Camera: NIDEK AFC-230 · no pharmacologic dilation · FOV: 45 degrees · 848 x 848 pixels · diabetic retinopathy graded by the modified Davis classification — 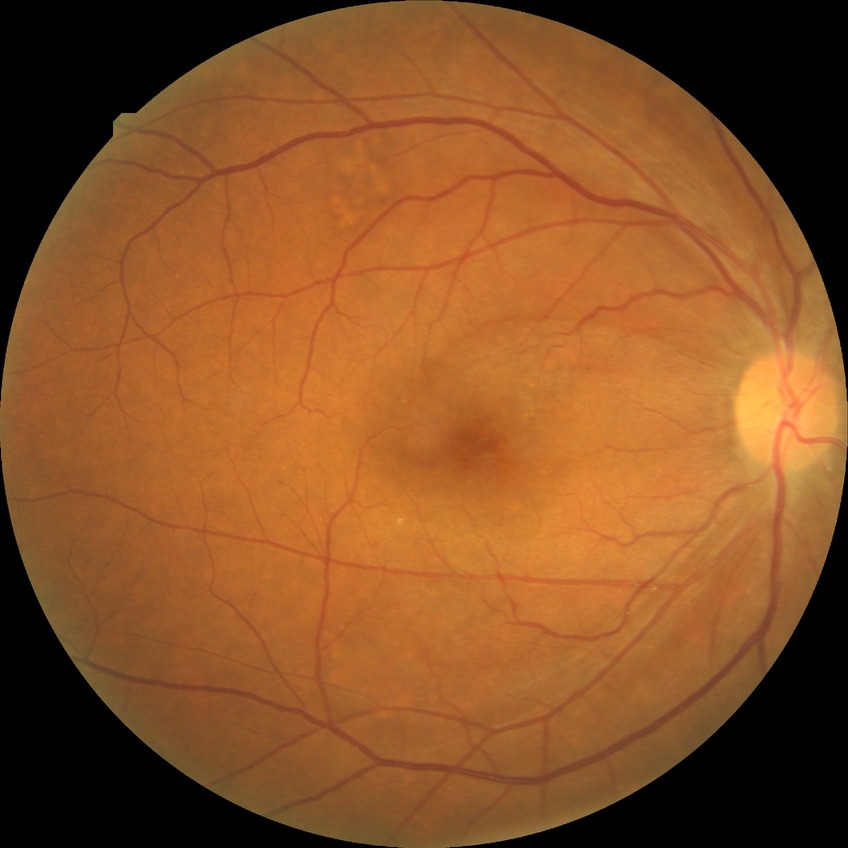

Diabetic retinopathy (DR) is NDR (no diabetic retinopathy).